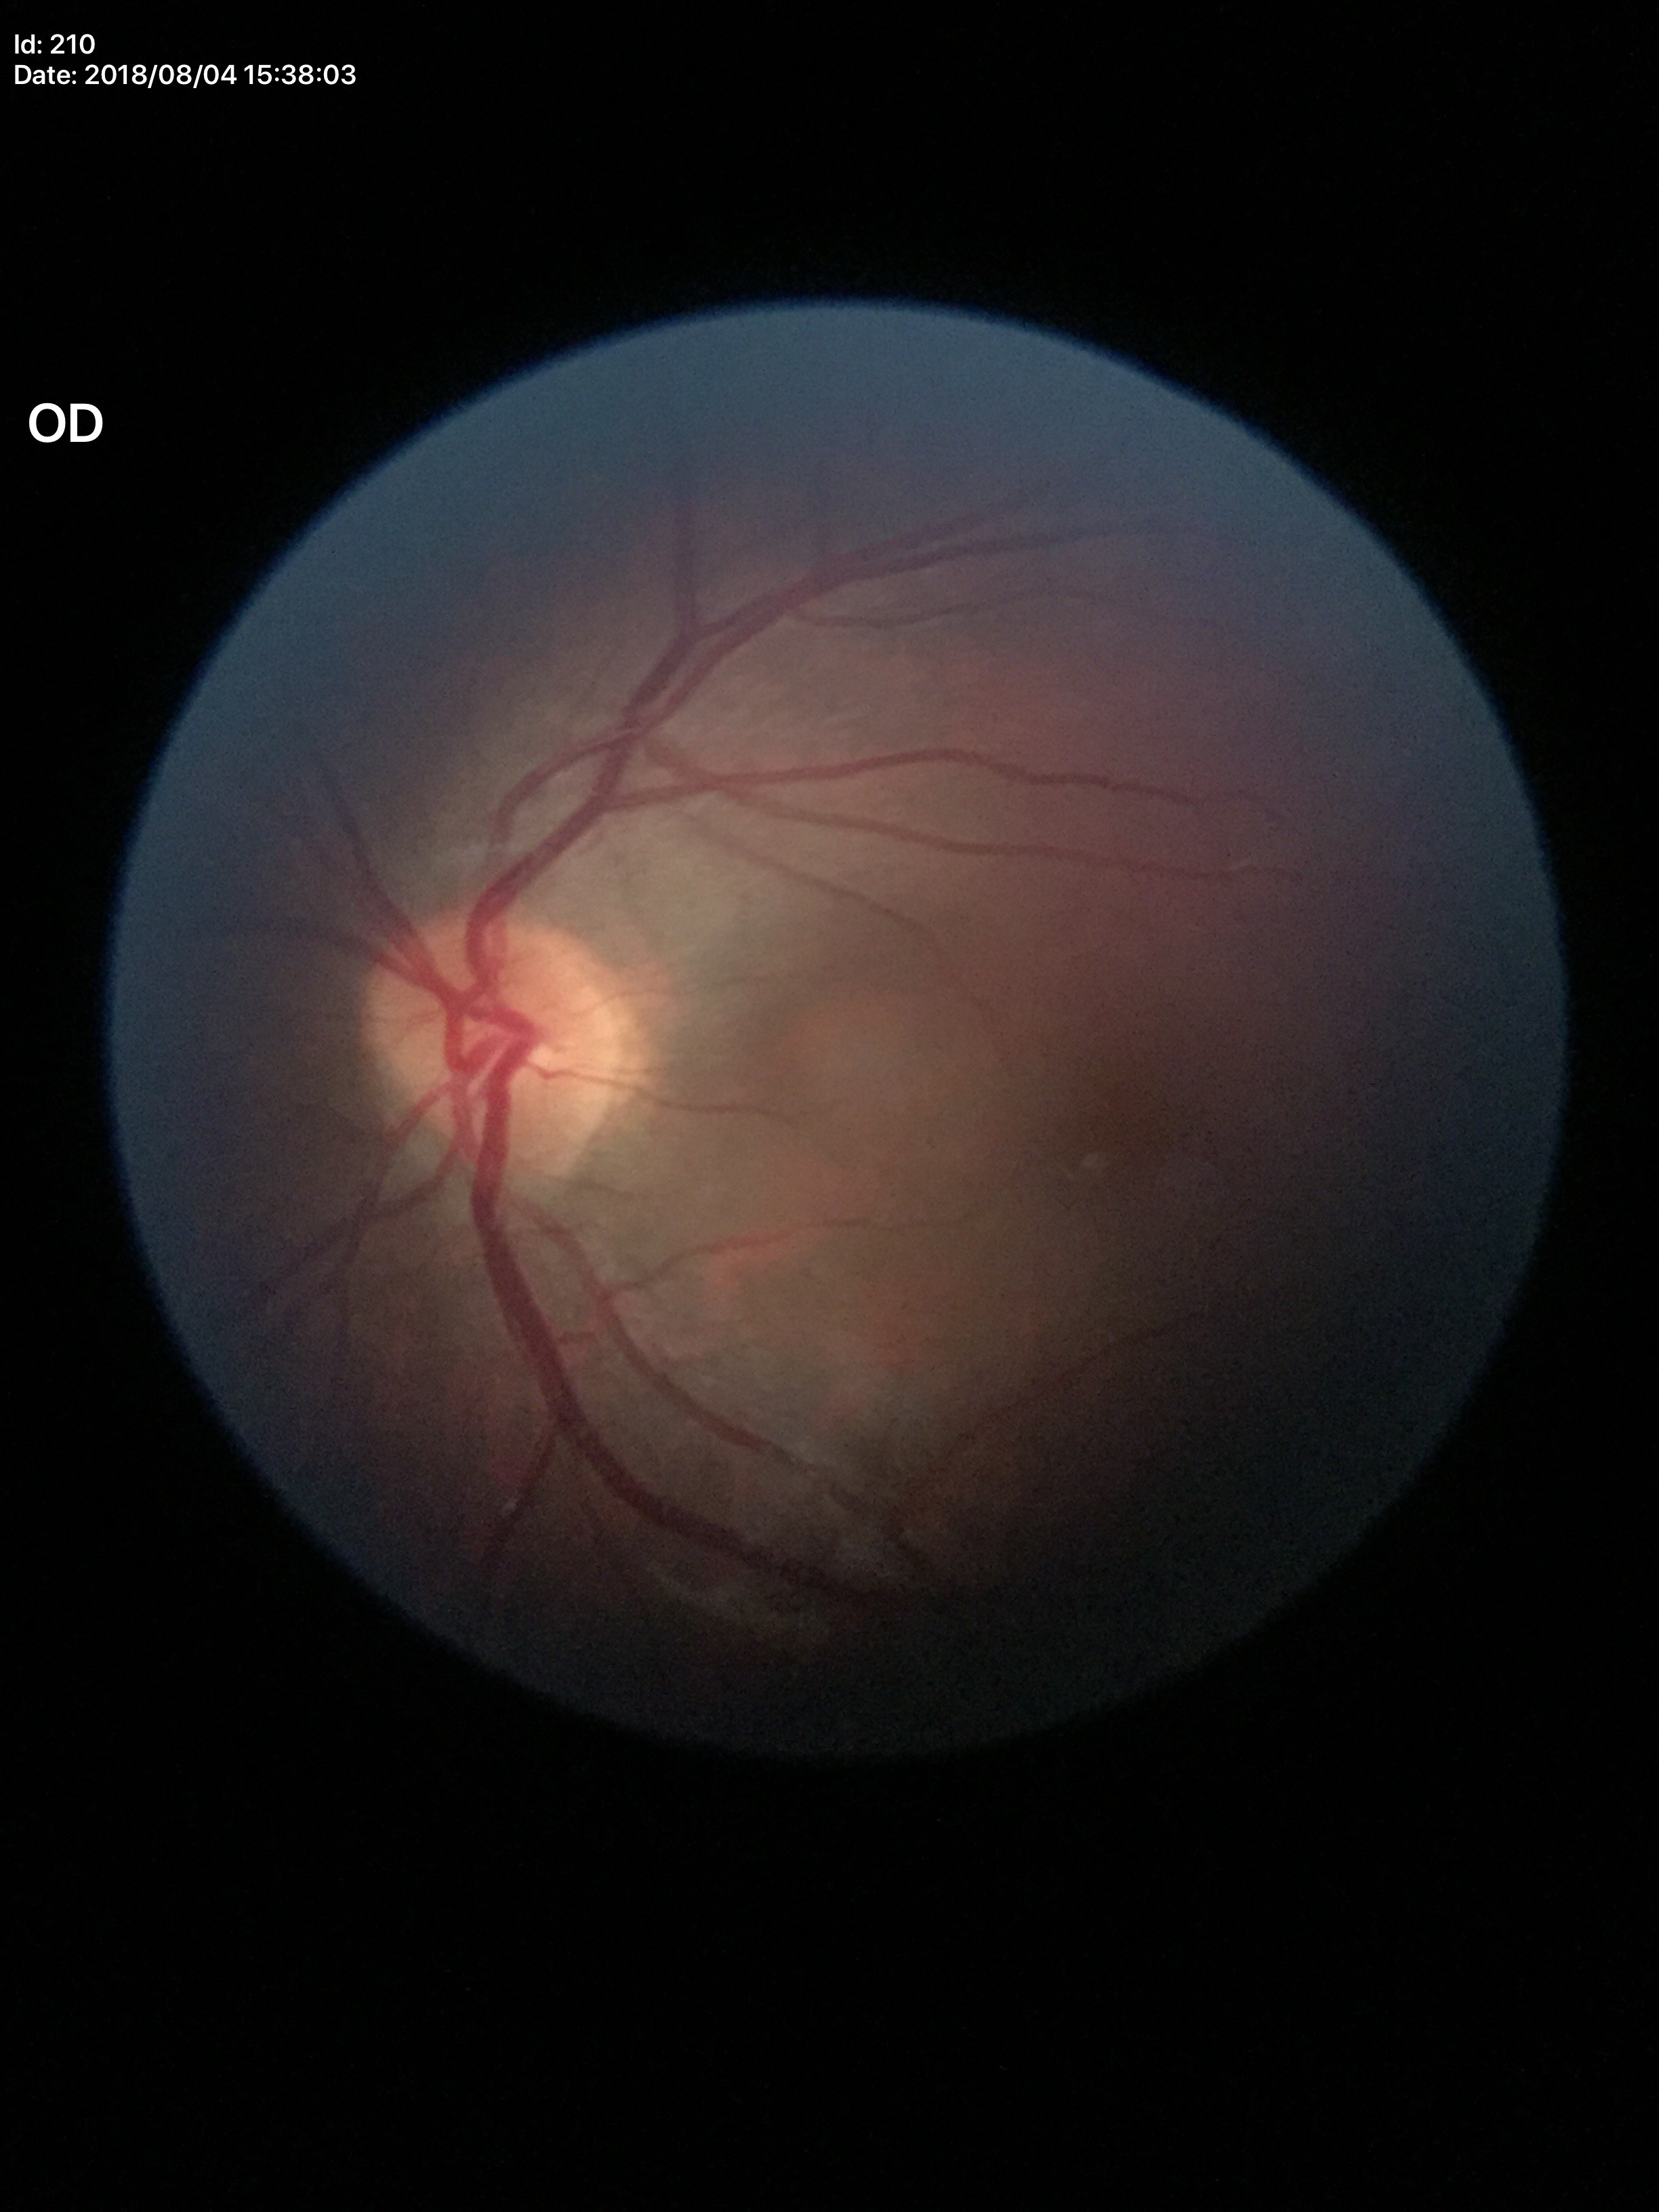

Annotations:
– Glaucoma screening impression · negative (unanimous normal call)
– VCDR · 0.48
– HCDR · 0.51